848x848. Posterior pole photograph. Diabetic retinopathy graded by the modified Davis classification
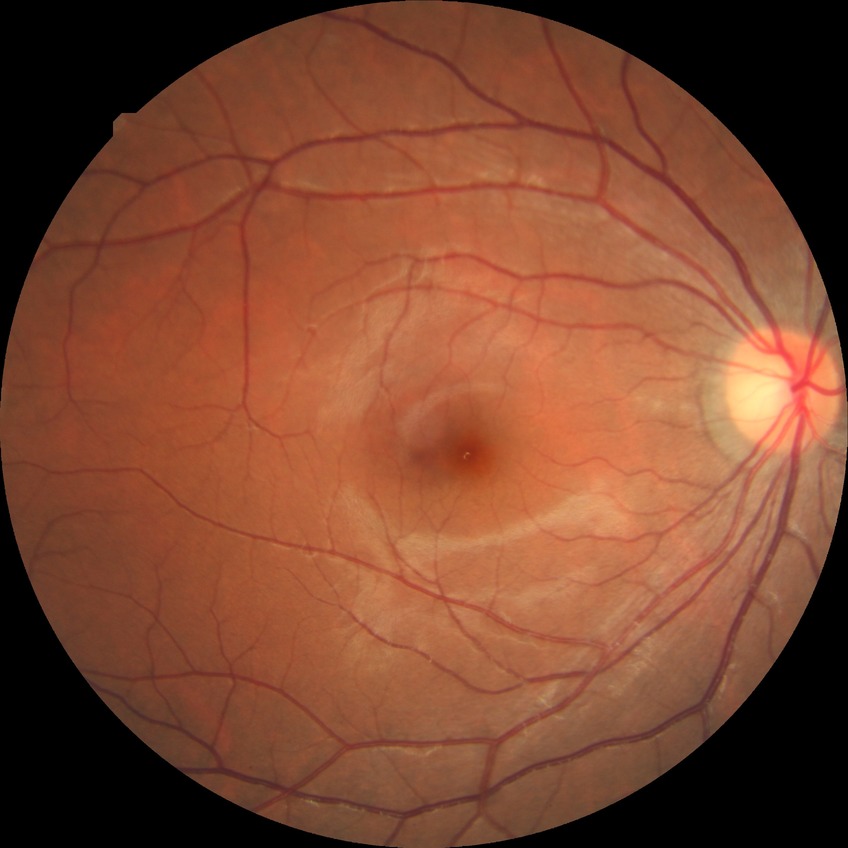
diabetic retinopathy severity: no diabetic retinopathy